Image size 2212x1659 · 45-degree field of view — 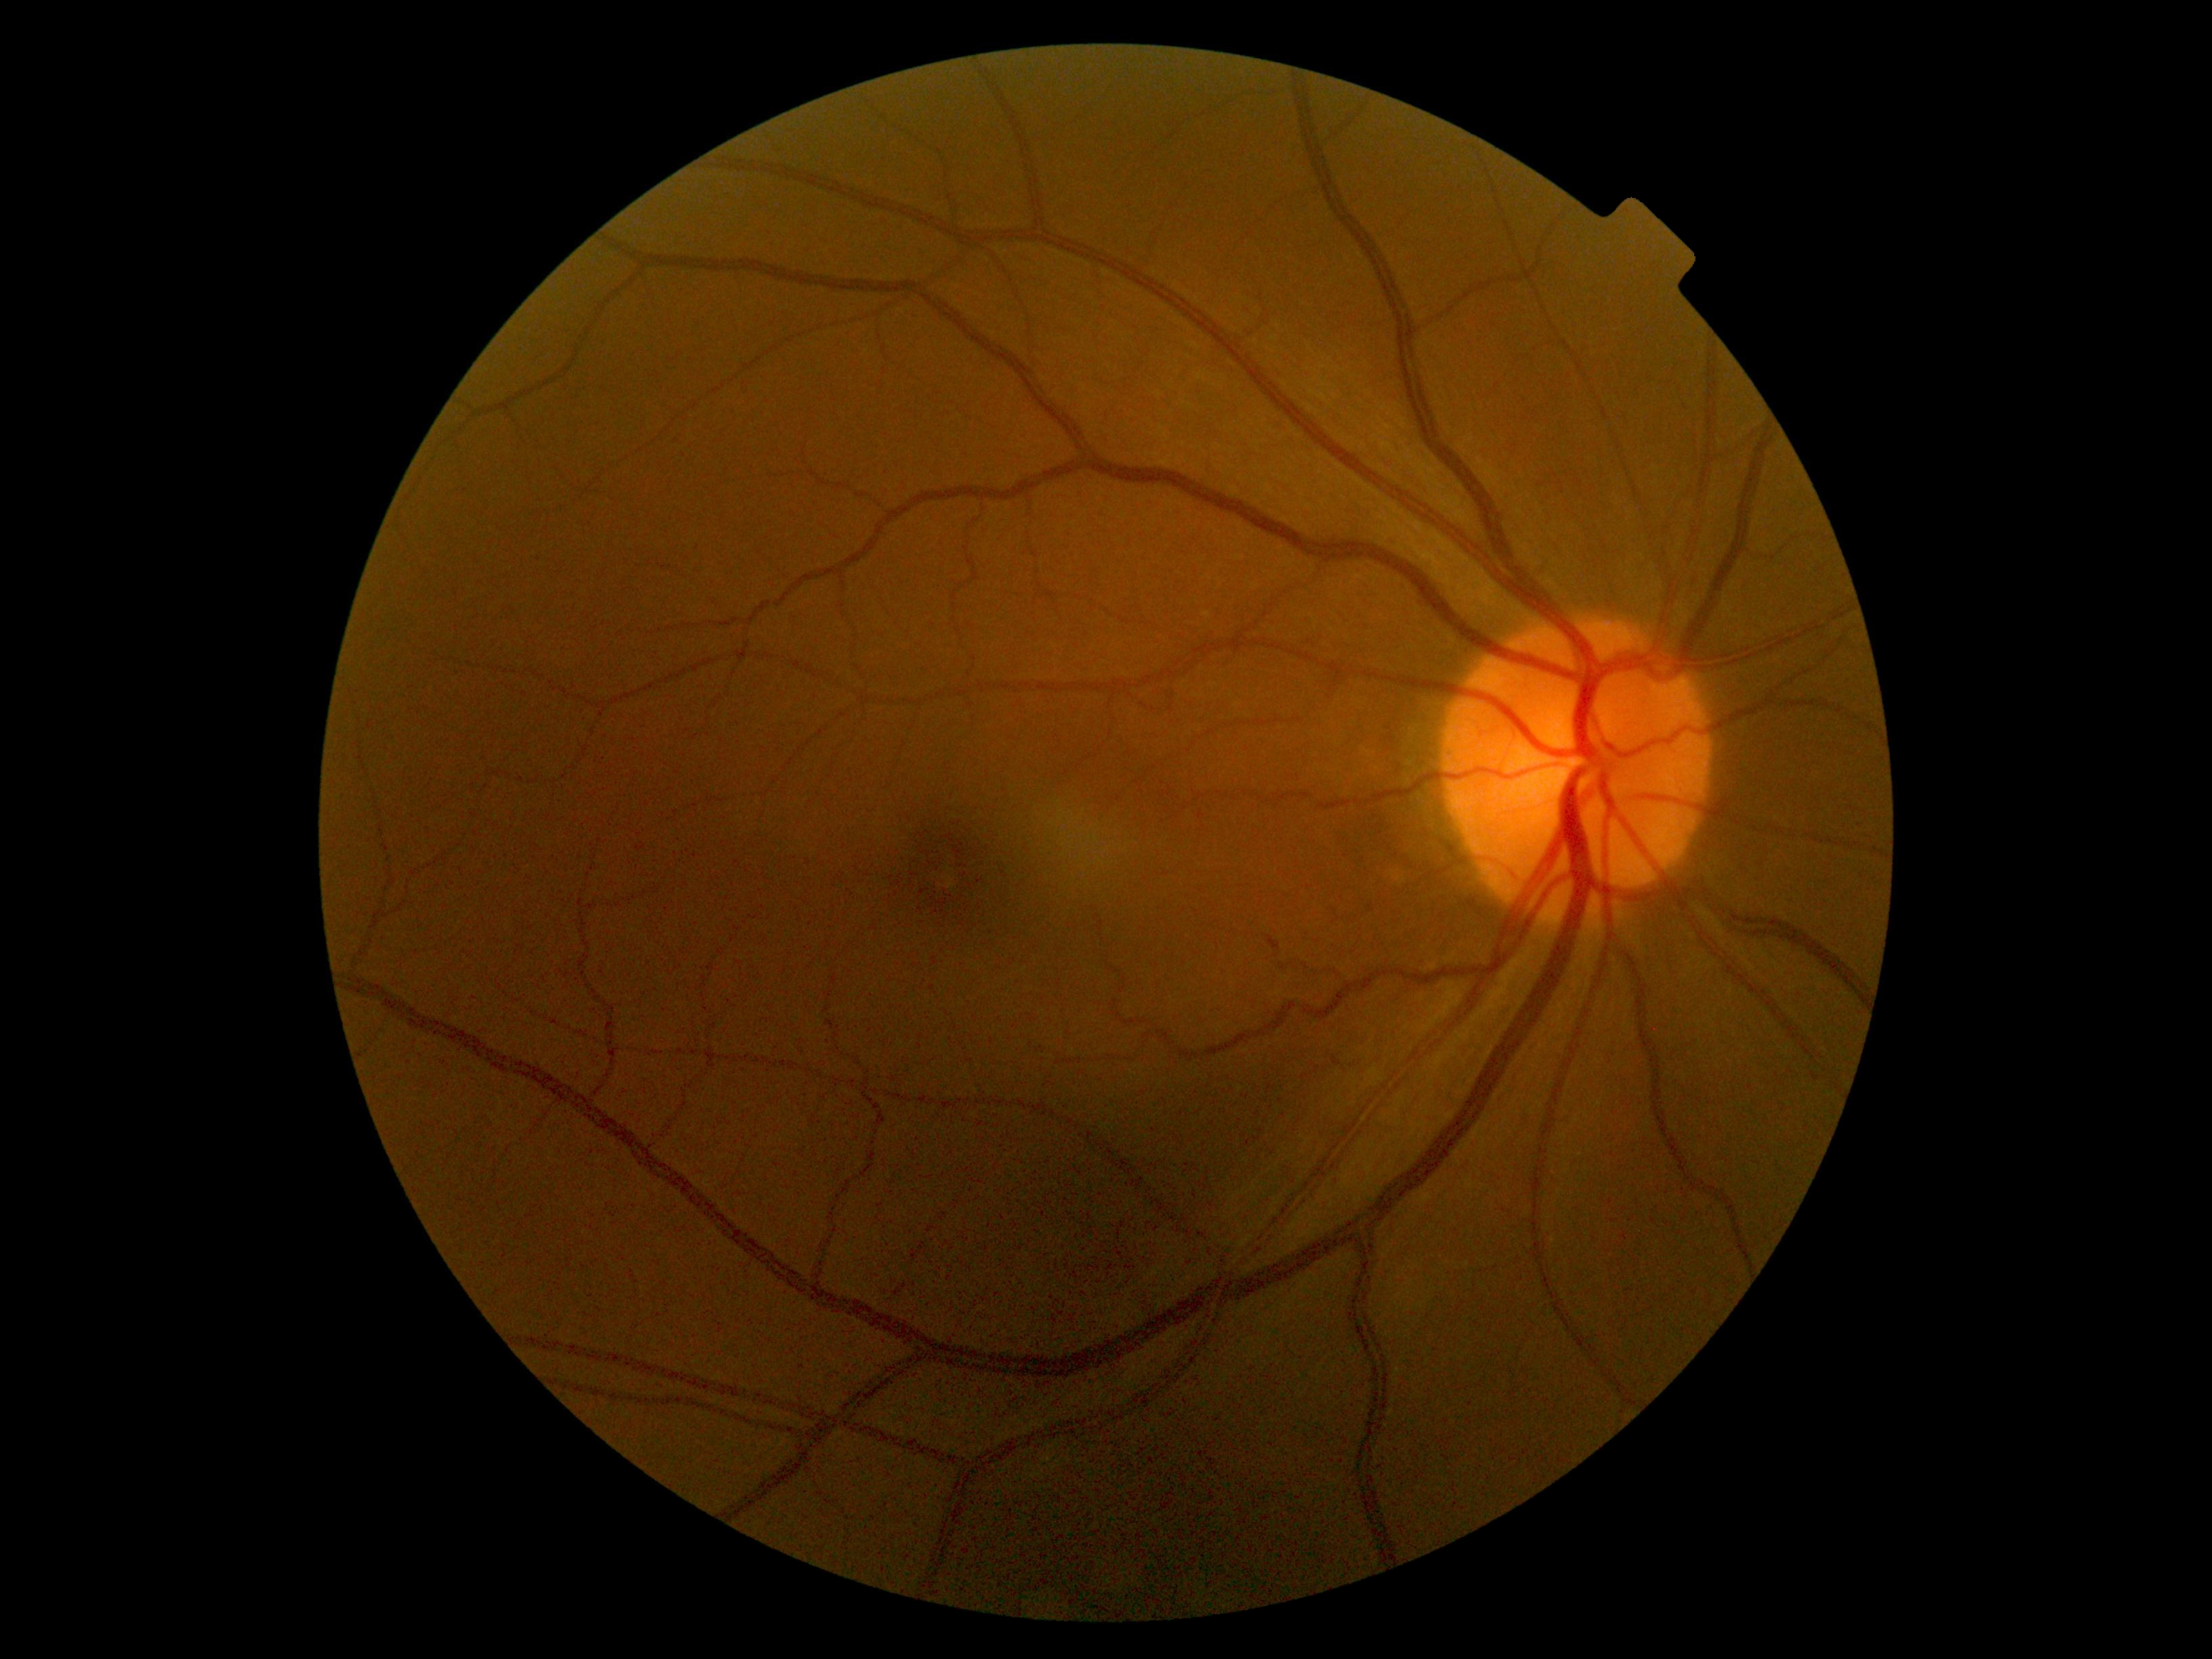

DR grade is 0/4 — no visible signs of diabetic retinopathy.